Diabetic retinopathy graded by the modified Davis classification · 848 by 848 pixels · no pharmacologic dilation: 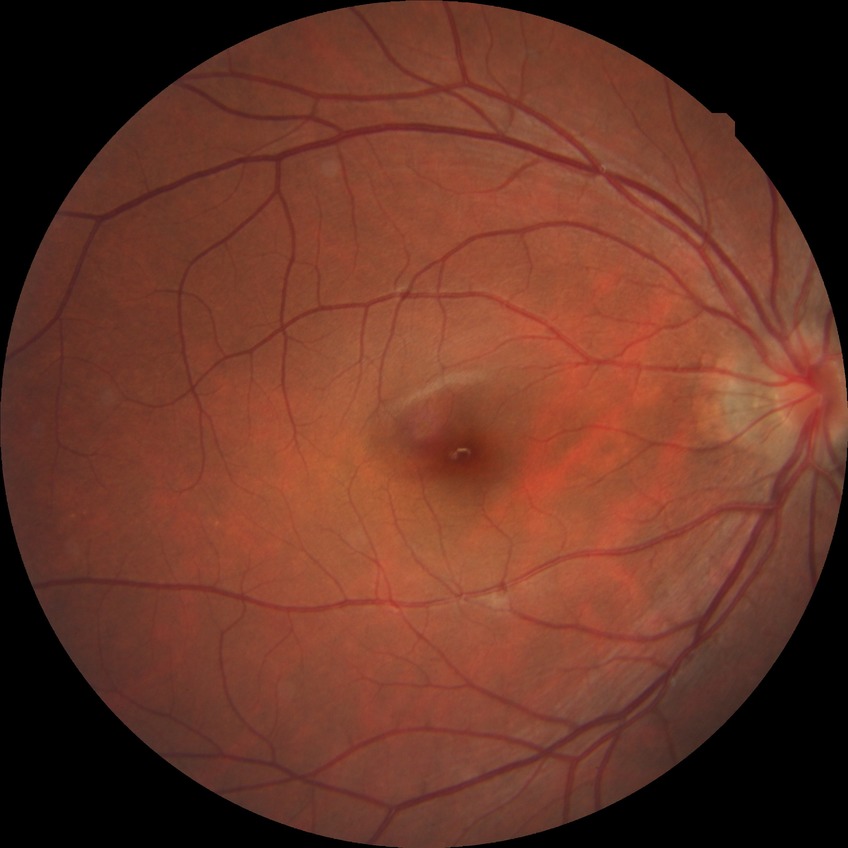 Davis grading=no diabetic retinopathy.